Remidio FOP fundus camera. Color fundus photograph. 1659 by 2212 pixels:
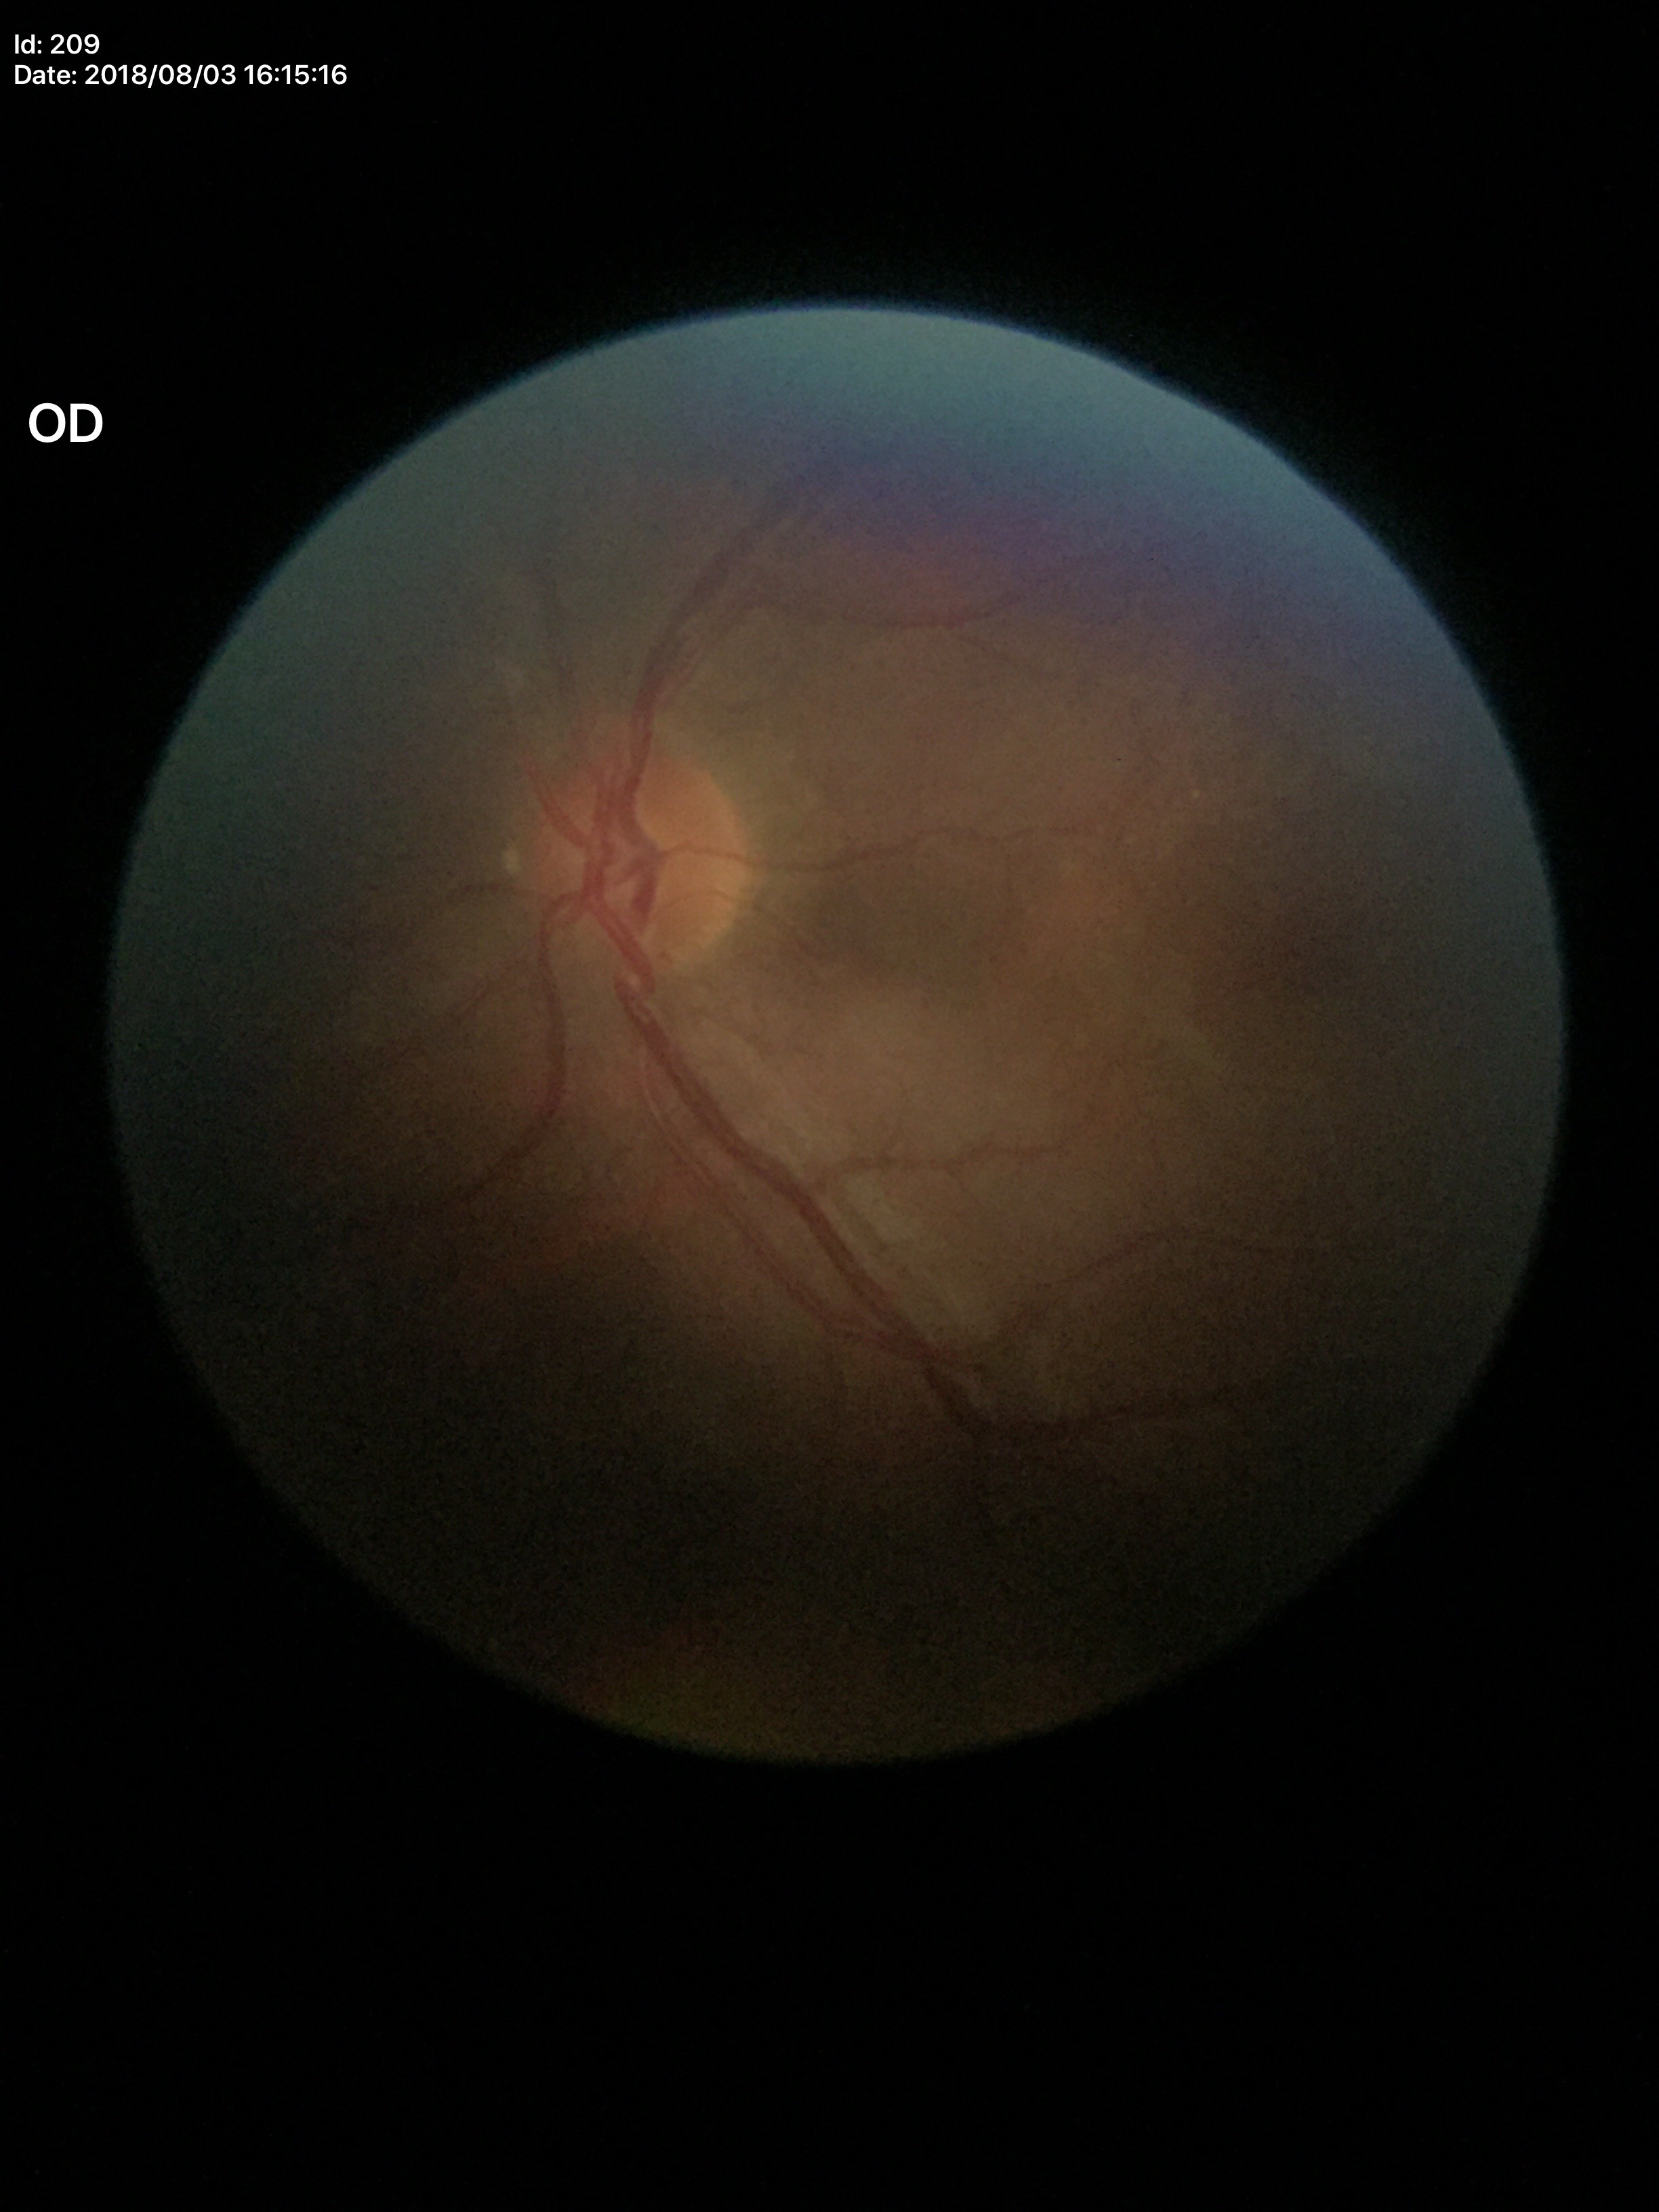 Glaucoma evaluation: negative; vertical cup-disc ratio: 0.48